Optic nerve head photograph · FOV 35° before cropping — 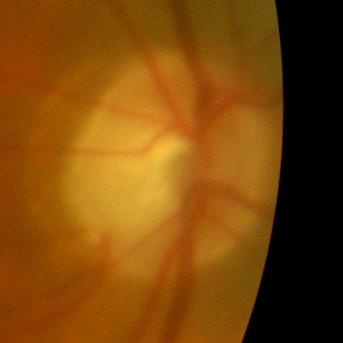 Demonstrates no glaucomatous optic neuropathy.